45° FOV · CFP · 2212x1659px:
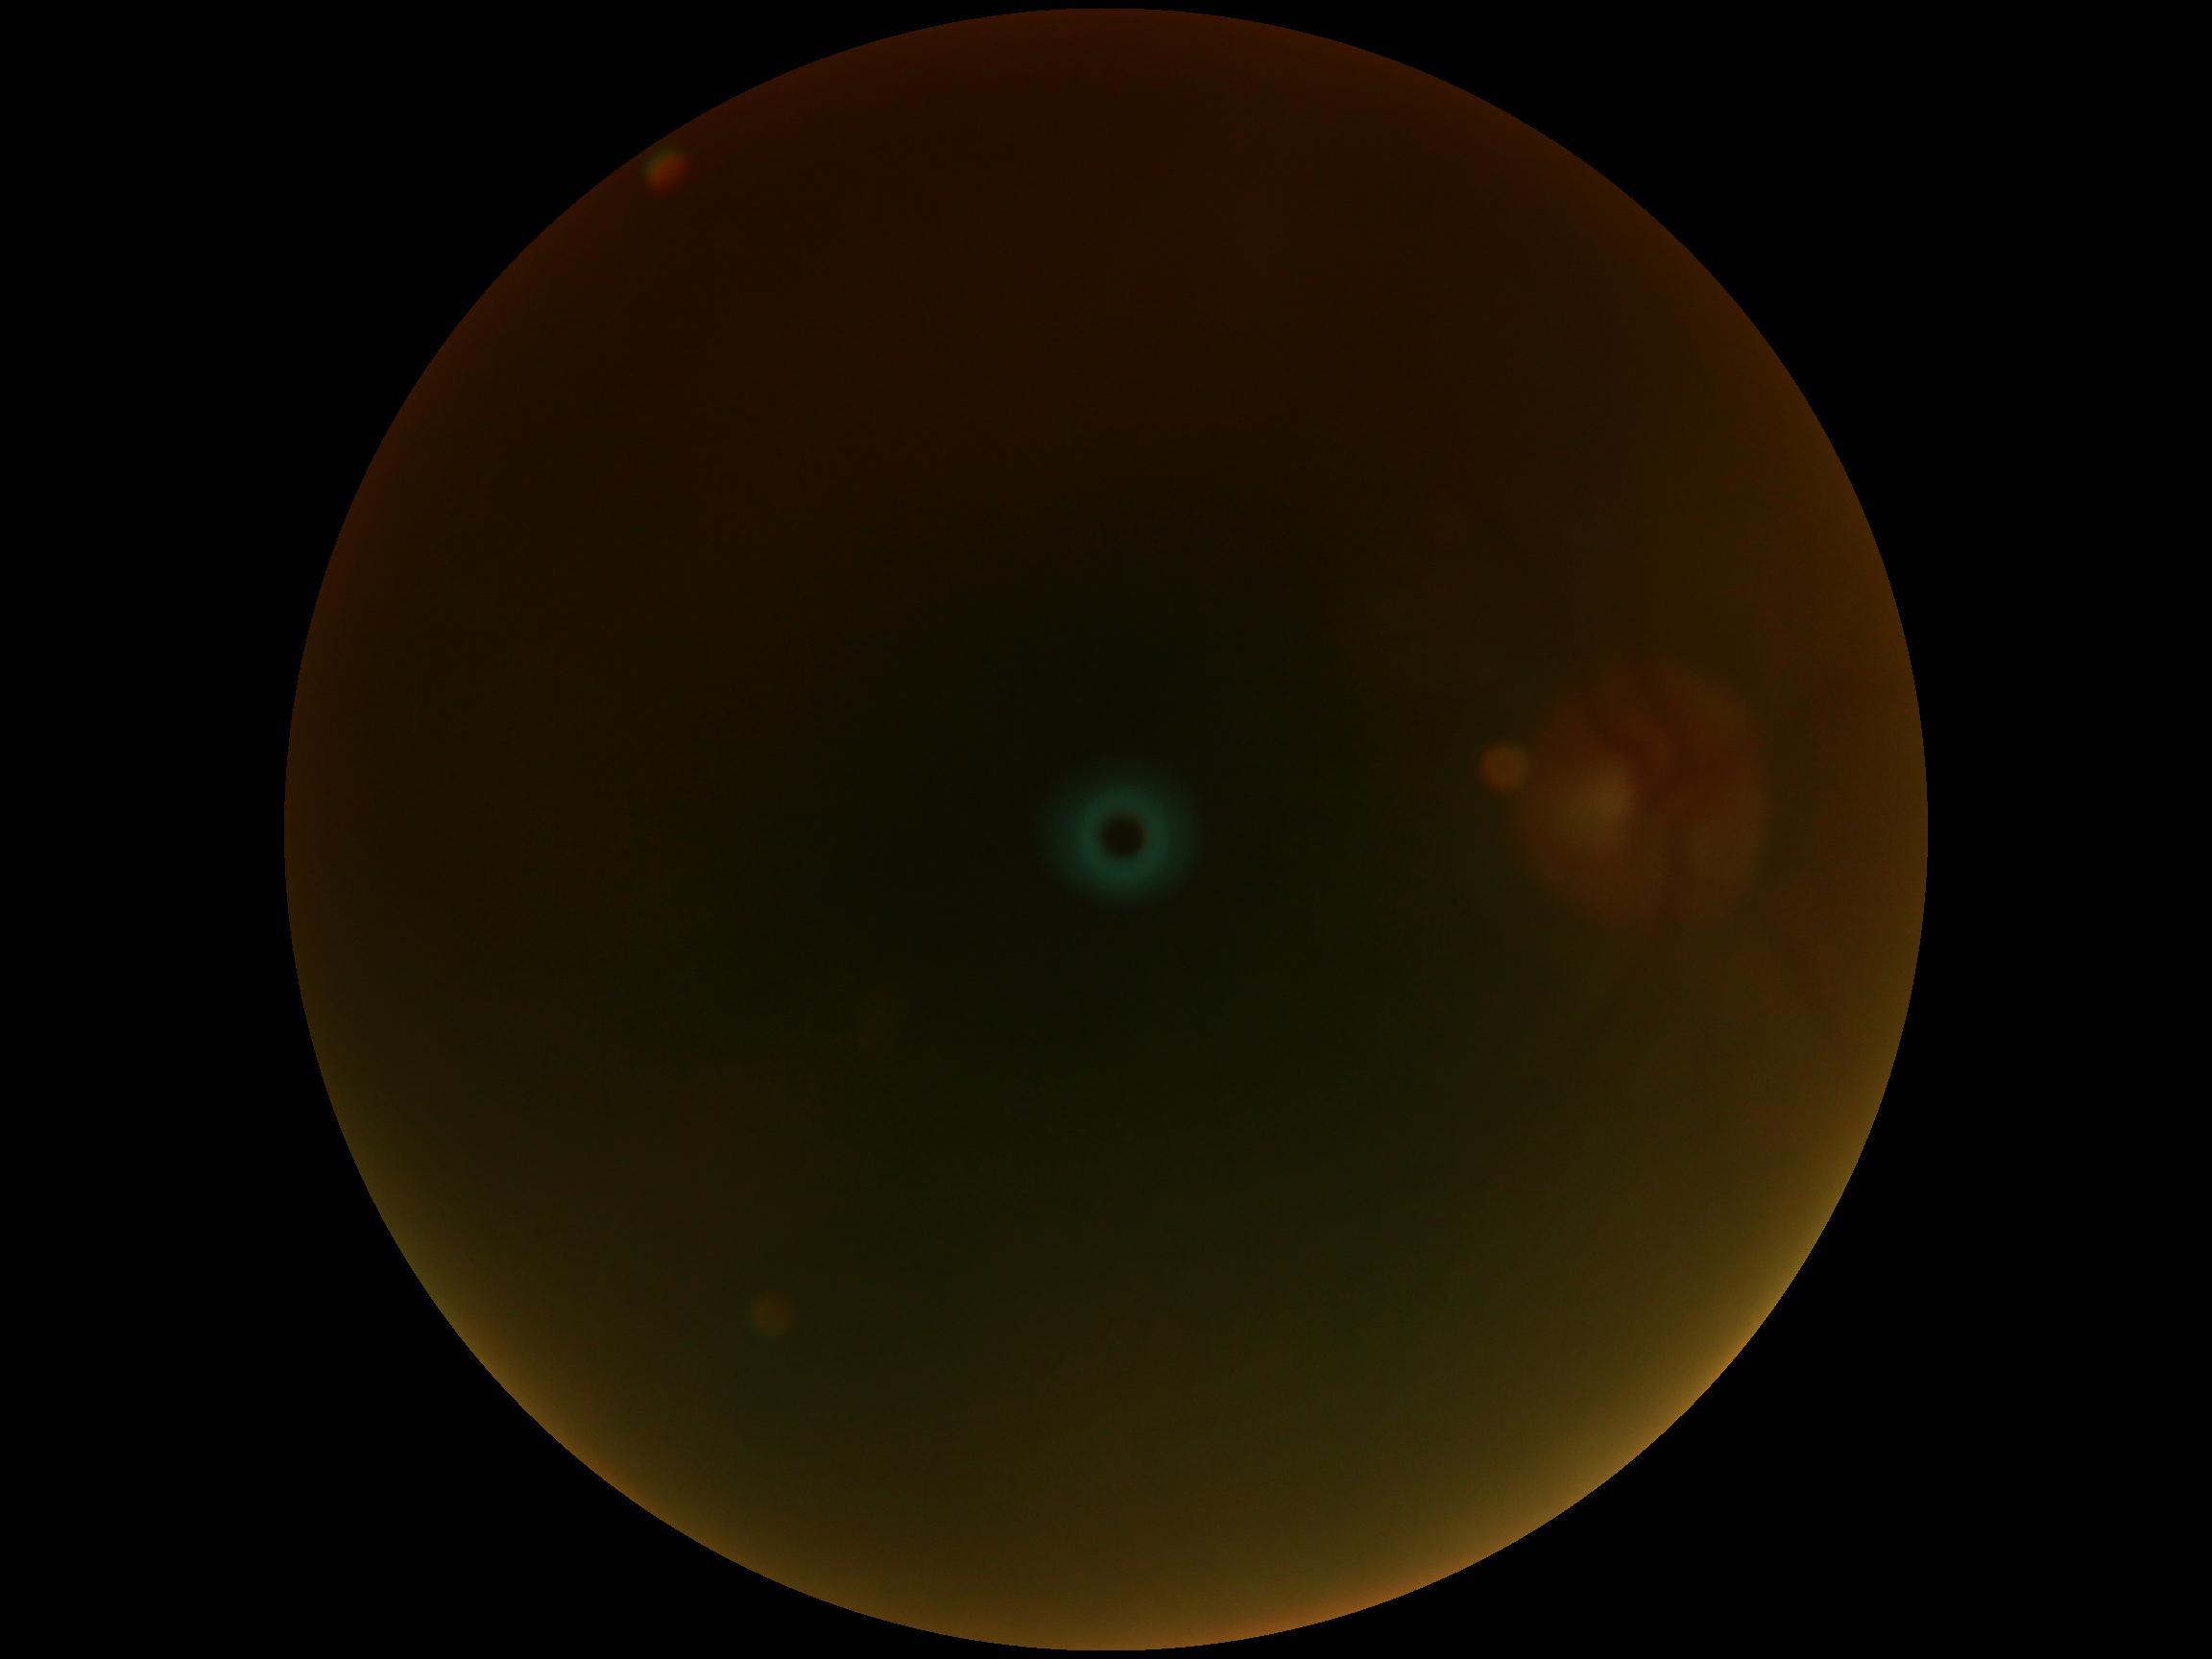
Quality too poor to assess for DR. DR severity: ungradable due to poor image quality.